Color fundus image
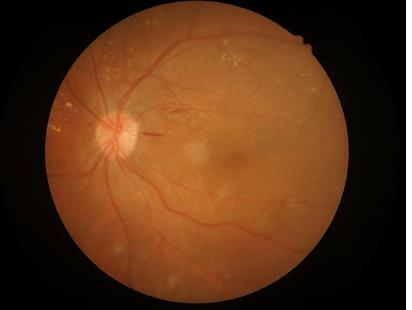
{"contrast": "good", "overall_quality": "adequate"}